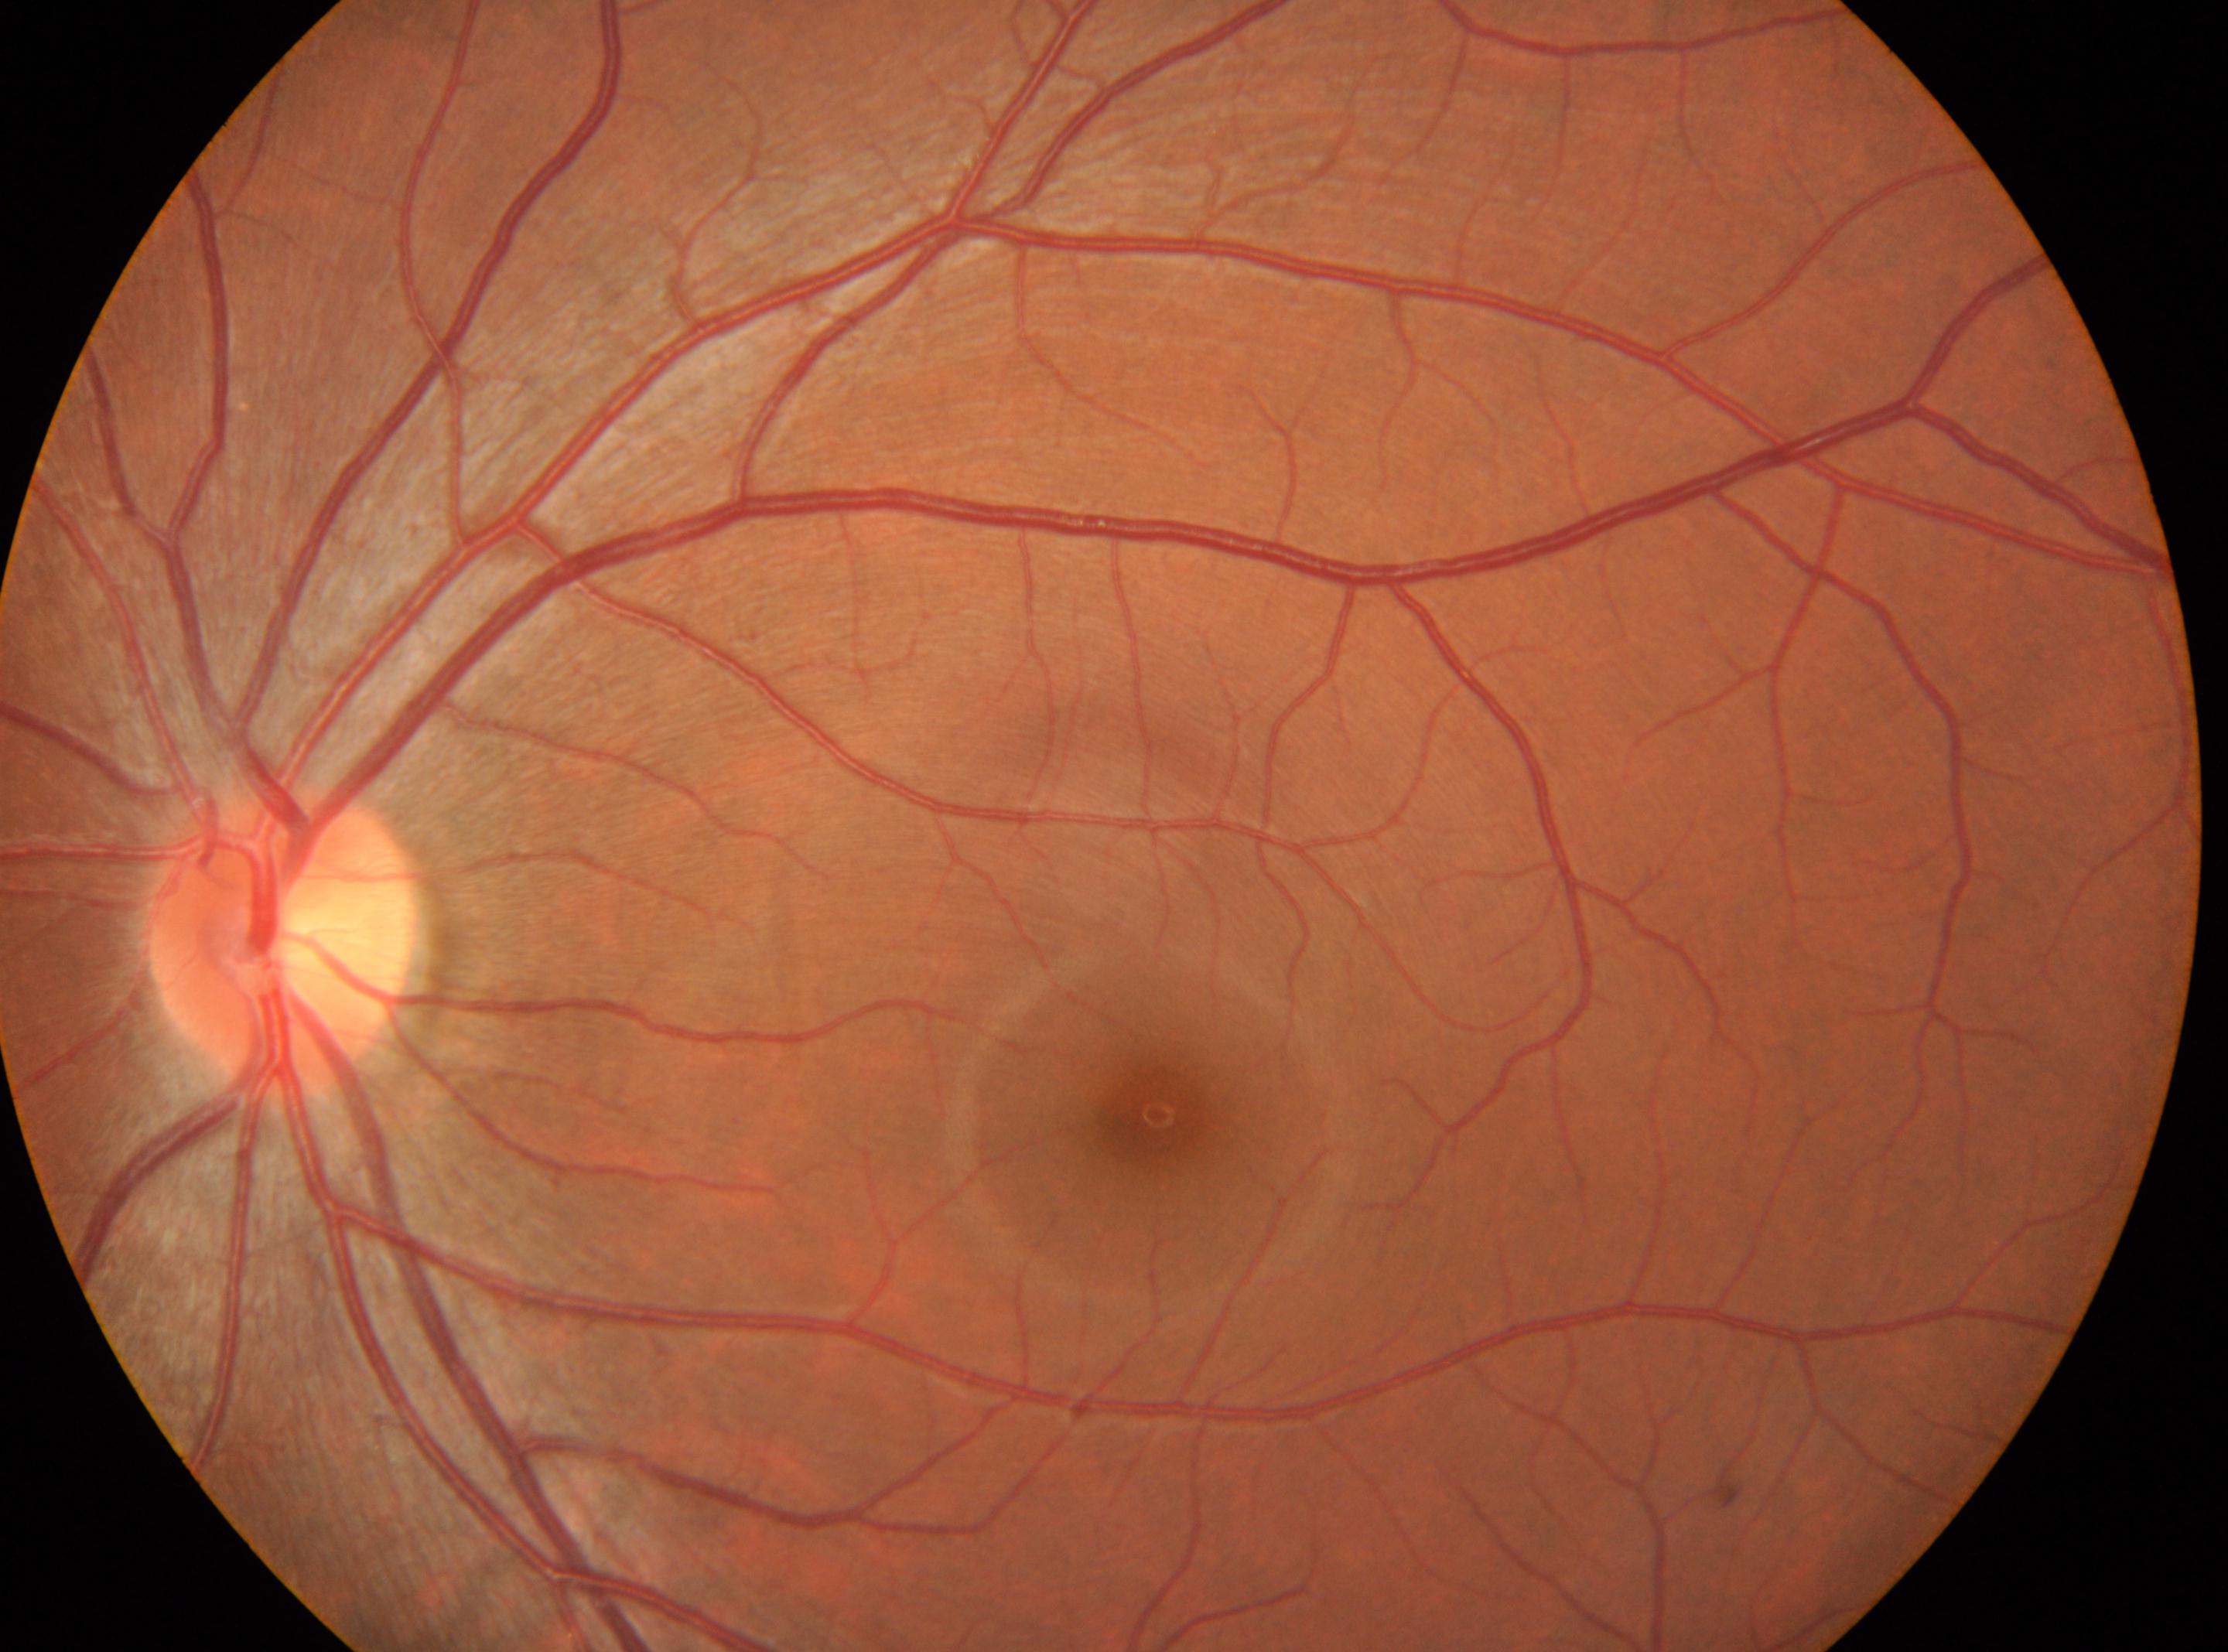   fovea: (x=1154, y=1114)
  optic_disc: (x=282, y=945)
  dr_grade: 0
  eye: left eye